Posterior pole photograph — 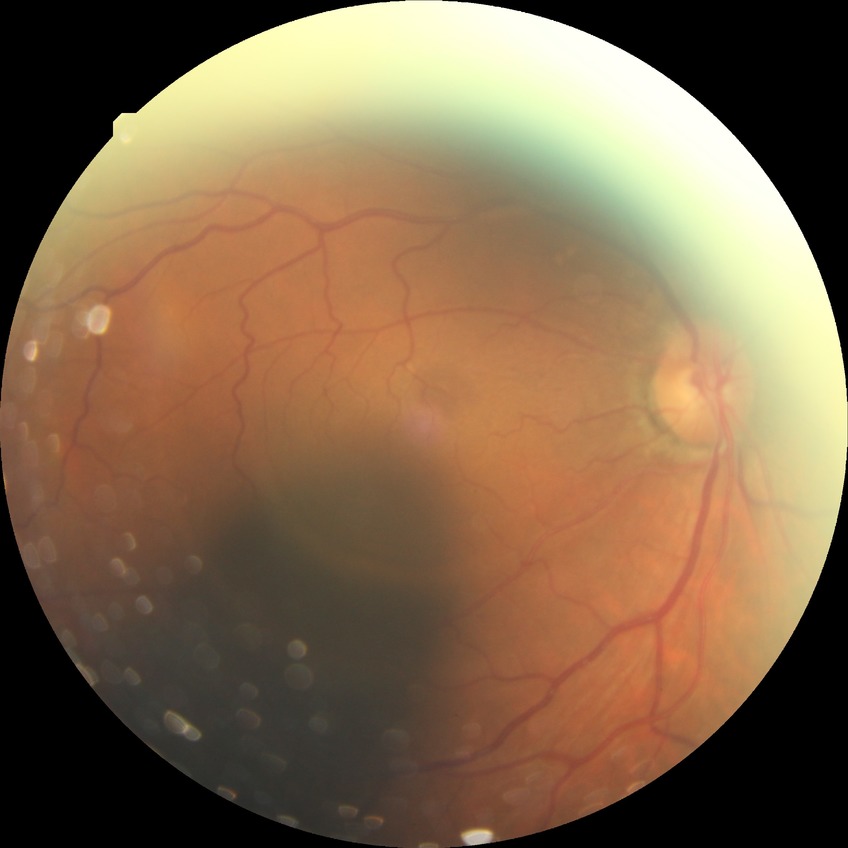

davis_grade: simple diabetic retinopathy